45° field of view.
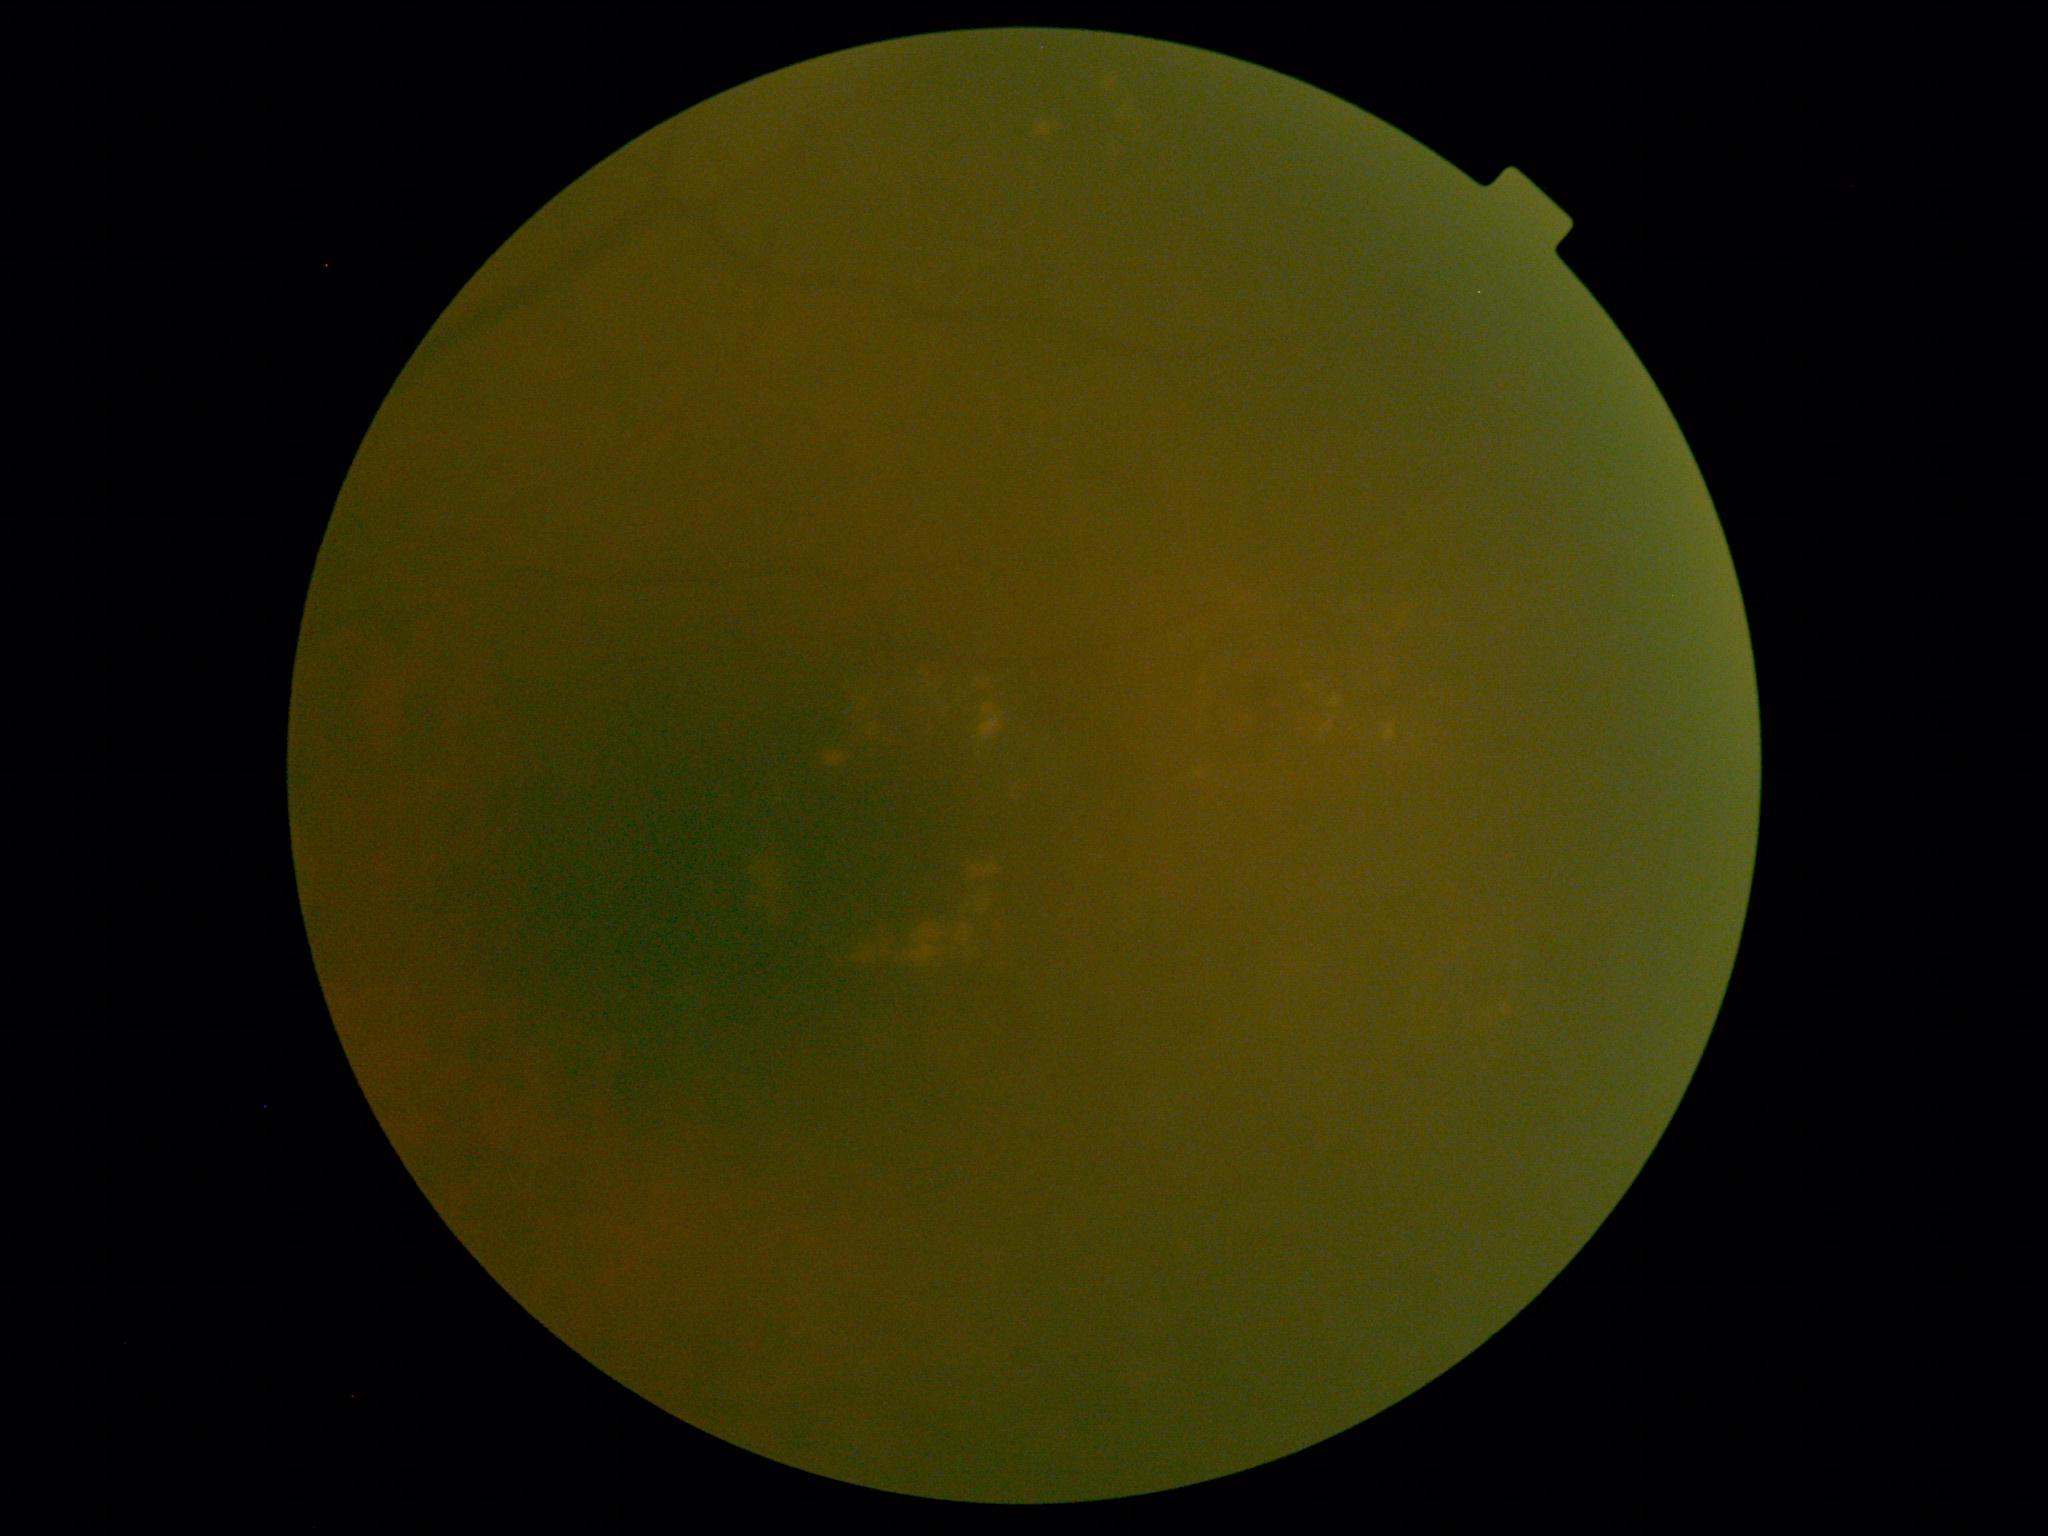
{
  "dr_category": "non-proliferative diabetic retinopathy",
  "dr_grade": "2"
}